Color fundus image, 45° FOV — 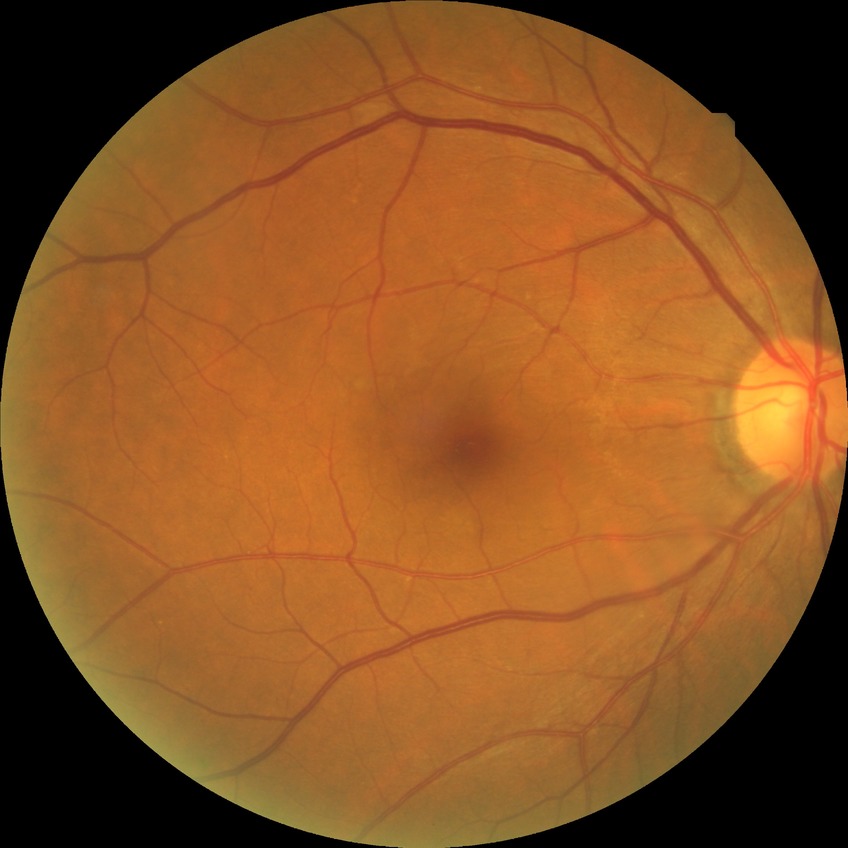

Davis grading: no diabetic retinopathy.